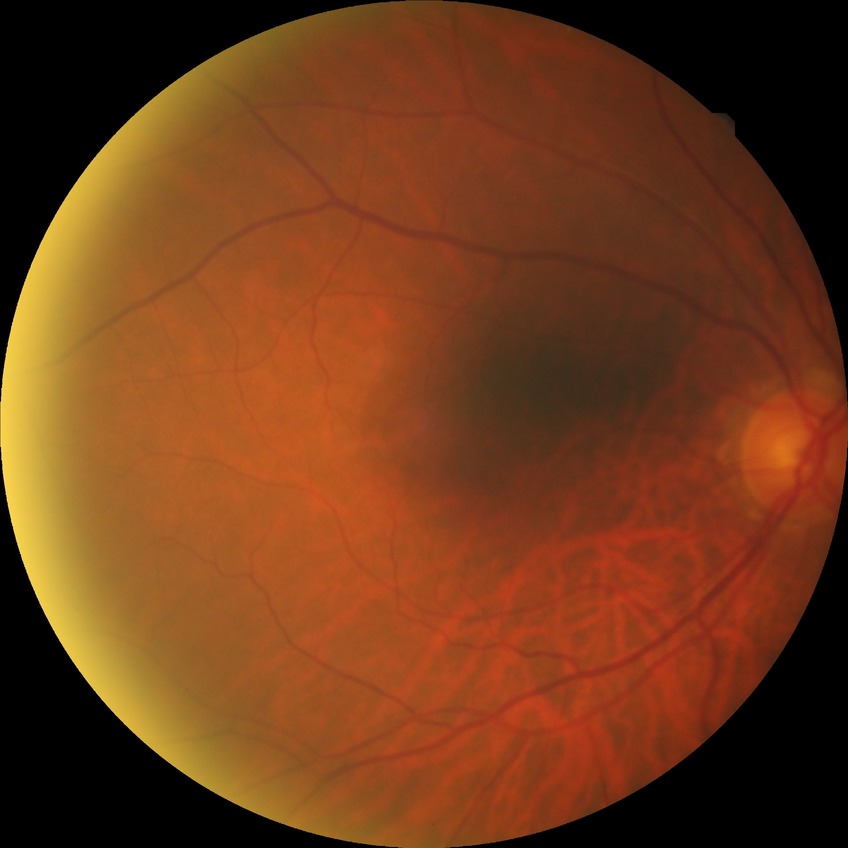
Davis grading is no diabetic retinopathy.